Color fundus image — 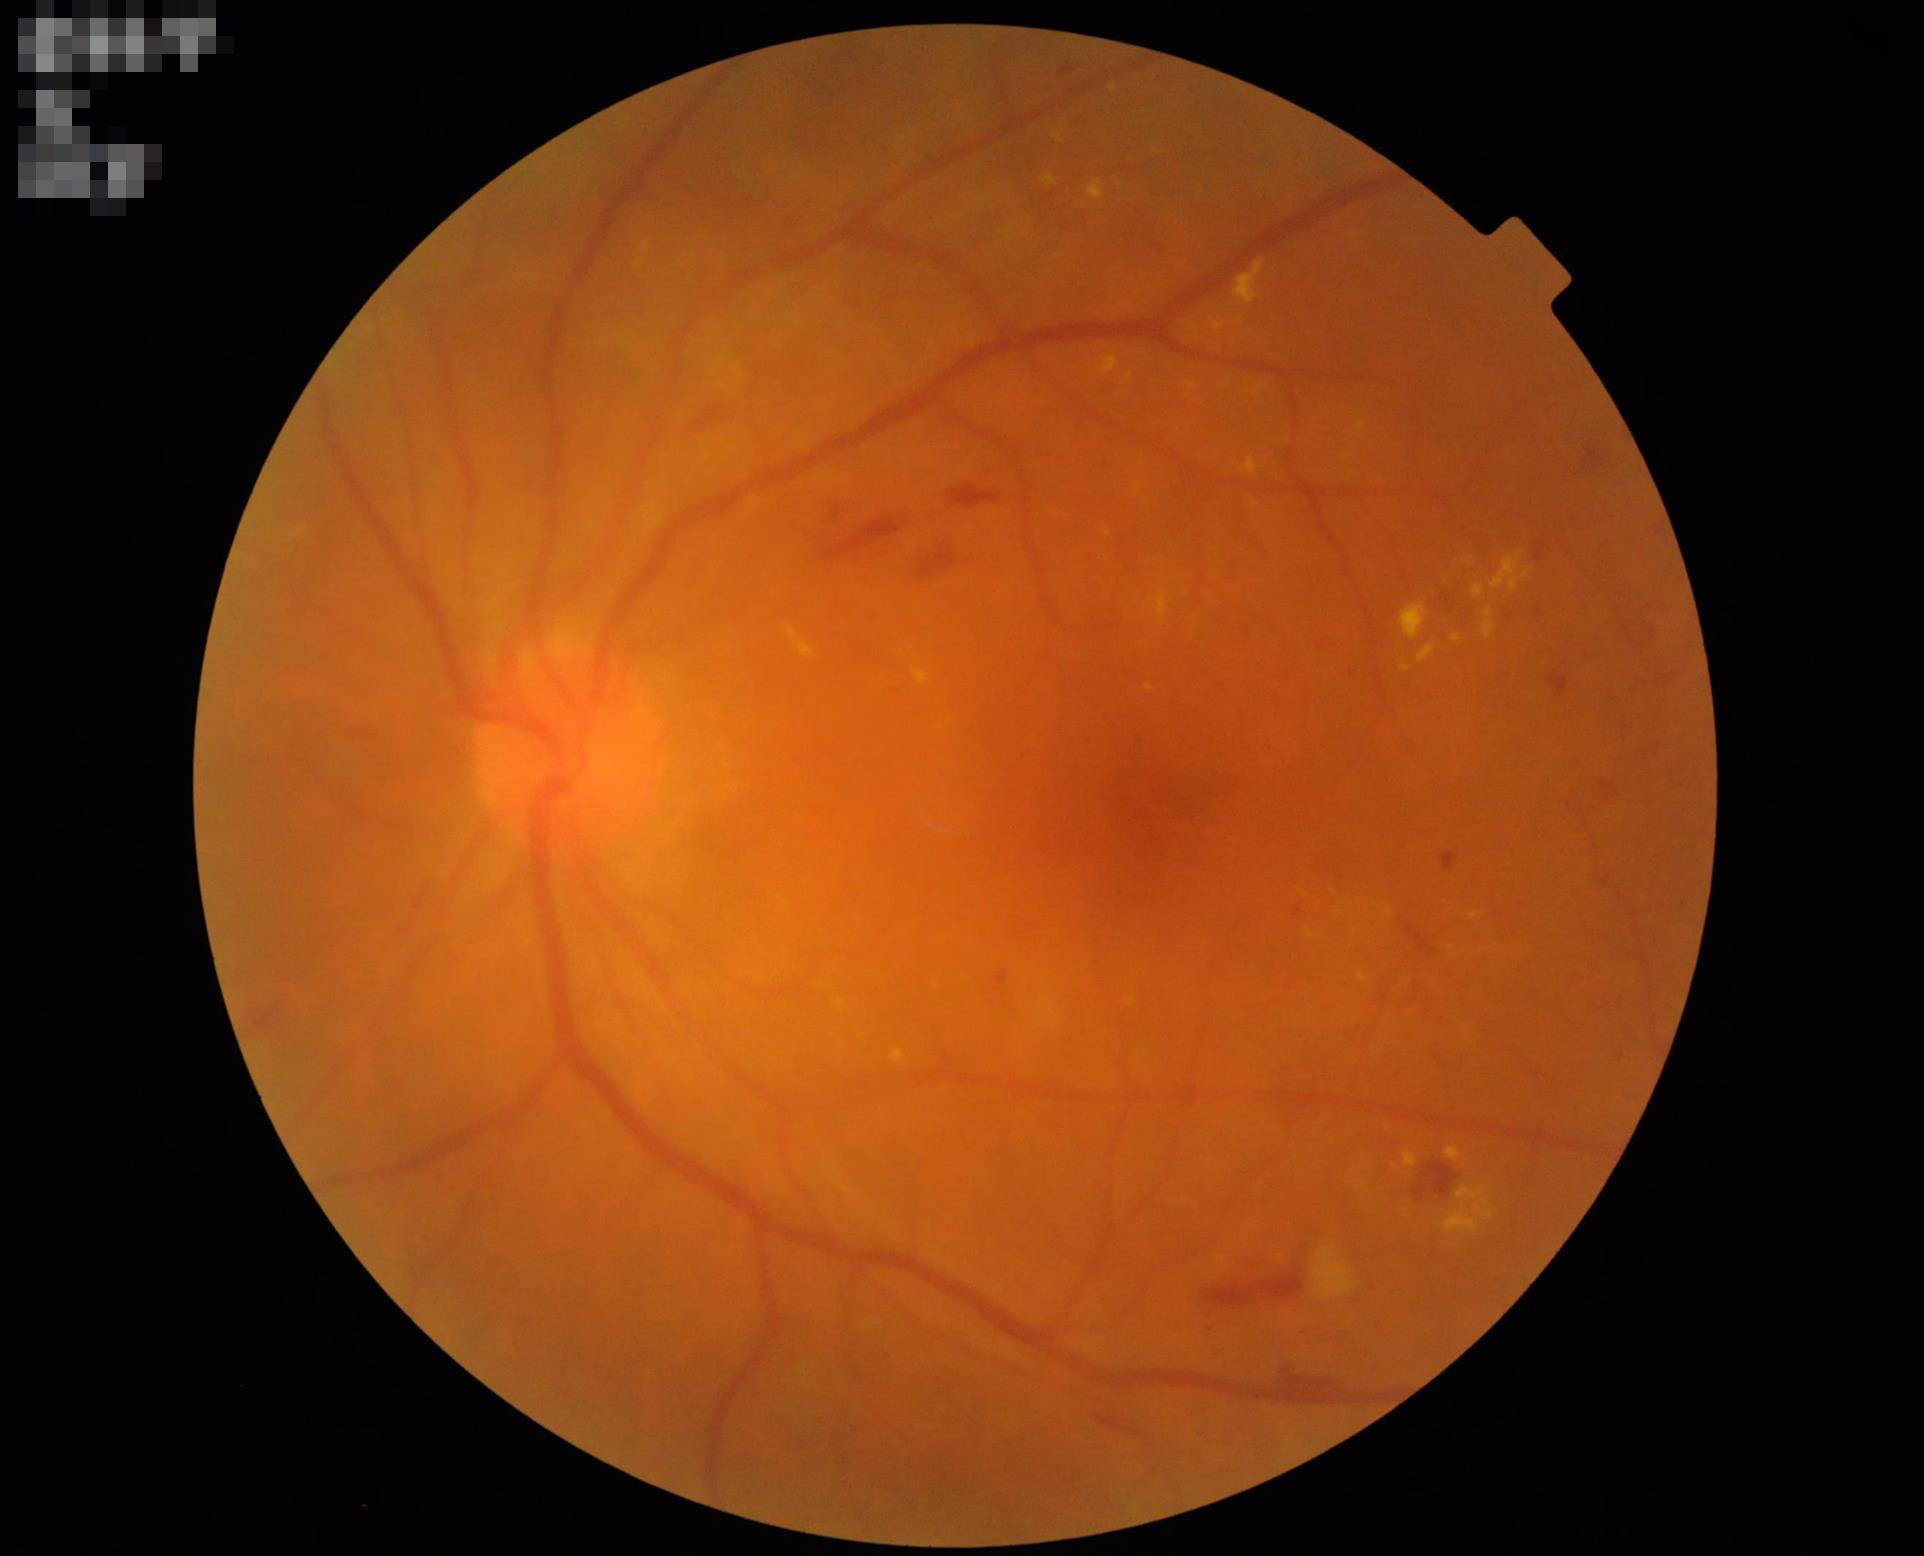 Clarity = out of focus, structures indistinct | Overall quality = good, gradable | Illumination = even and well-balanced.